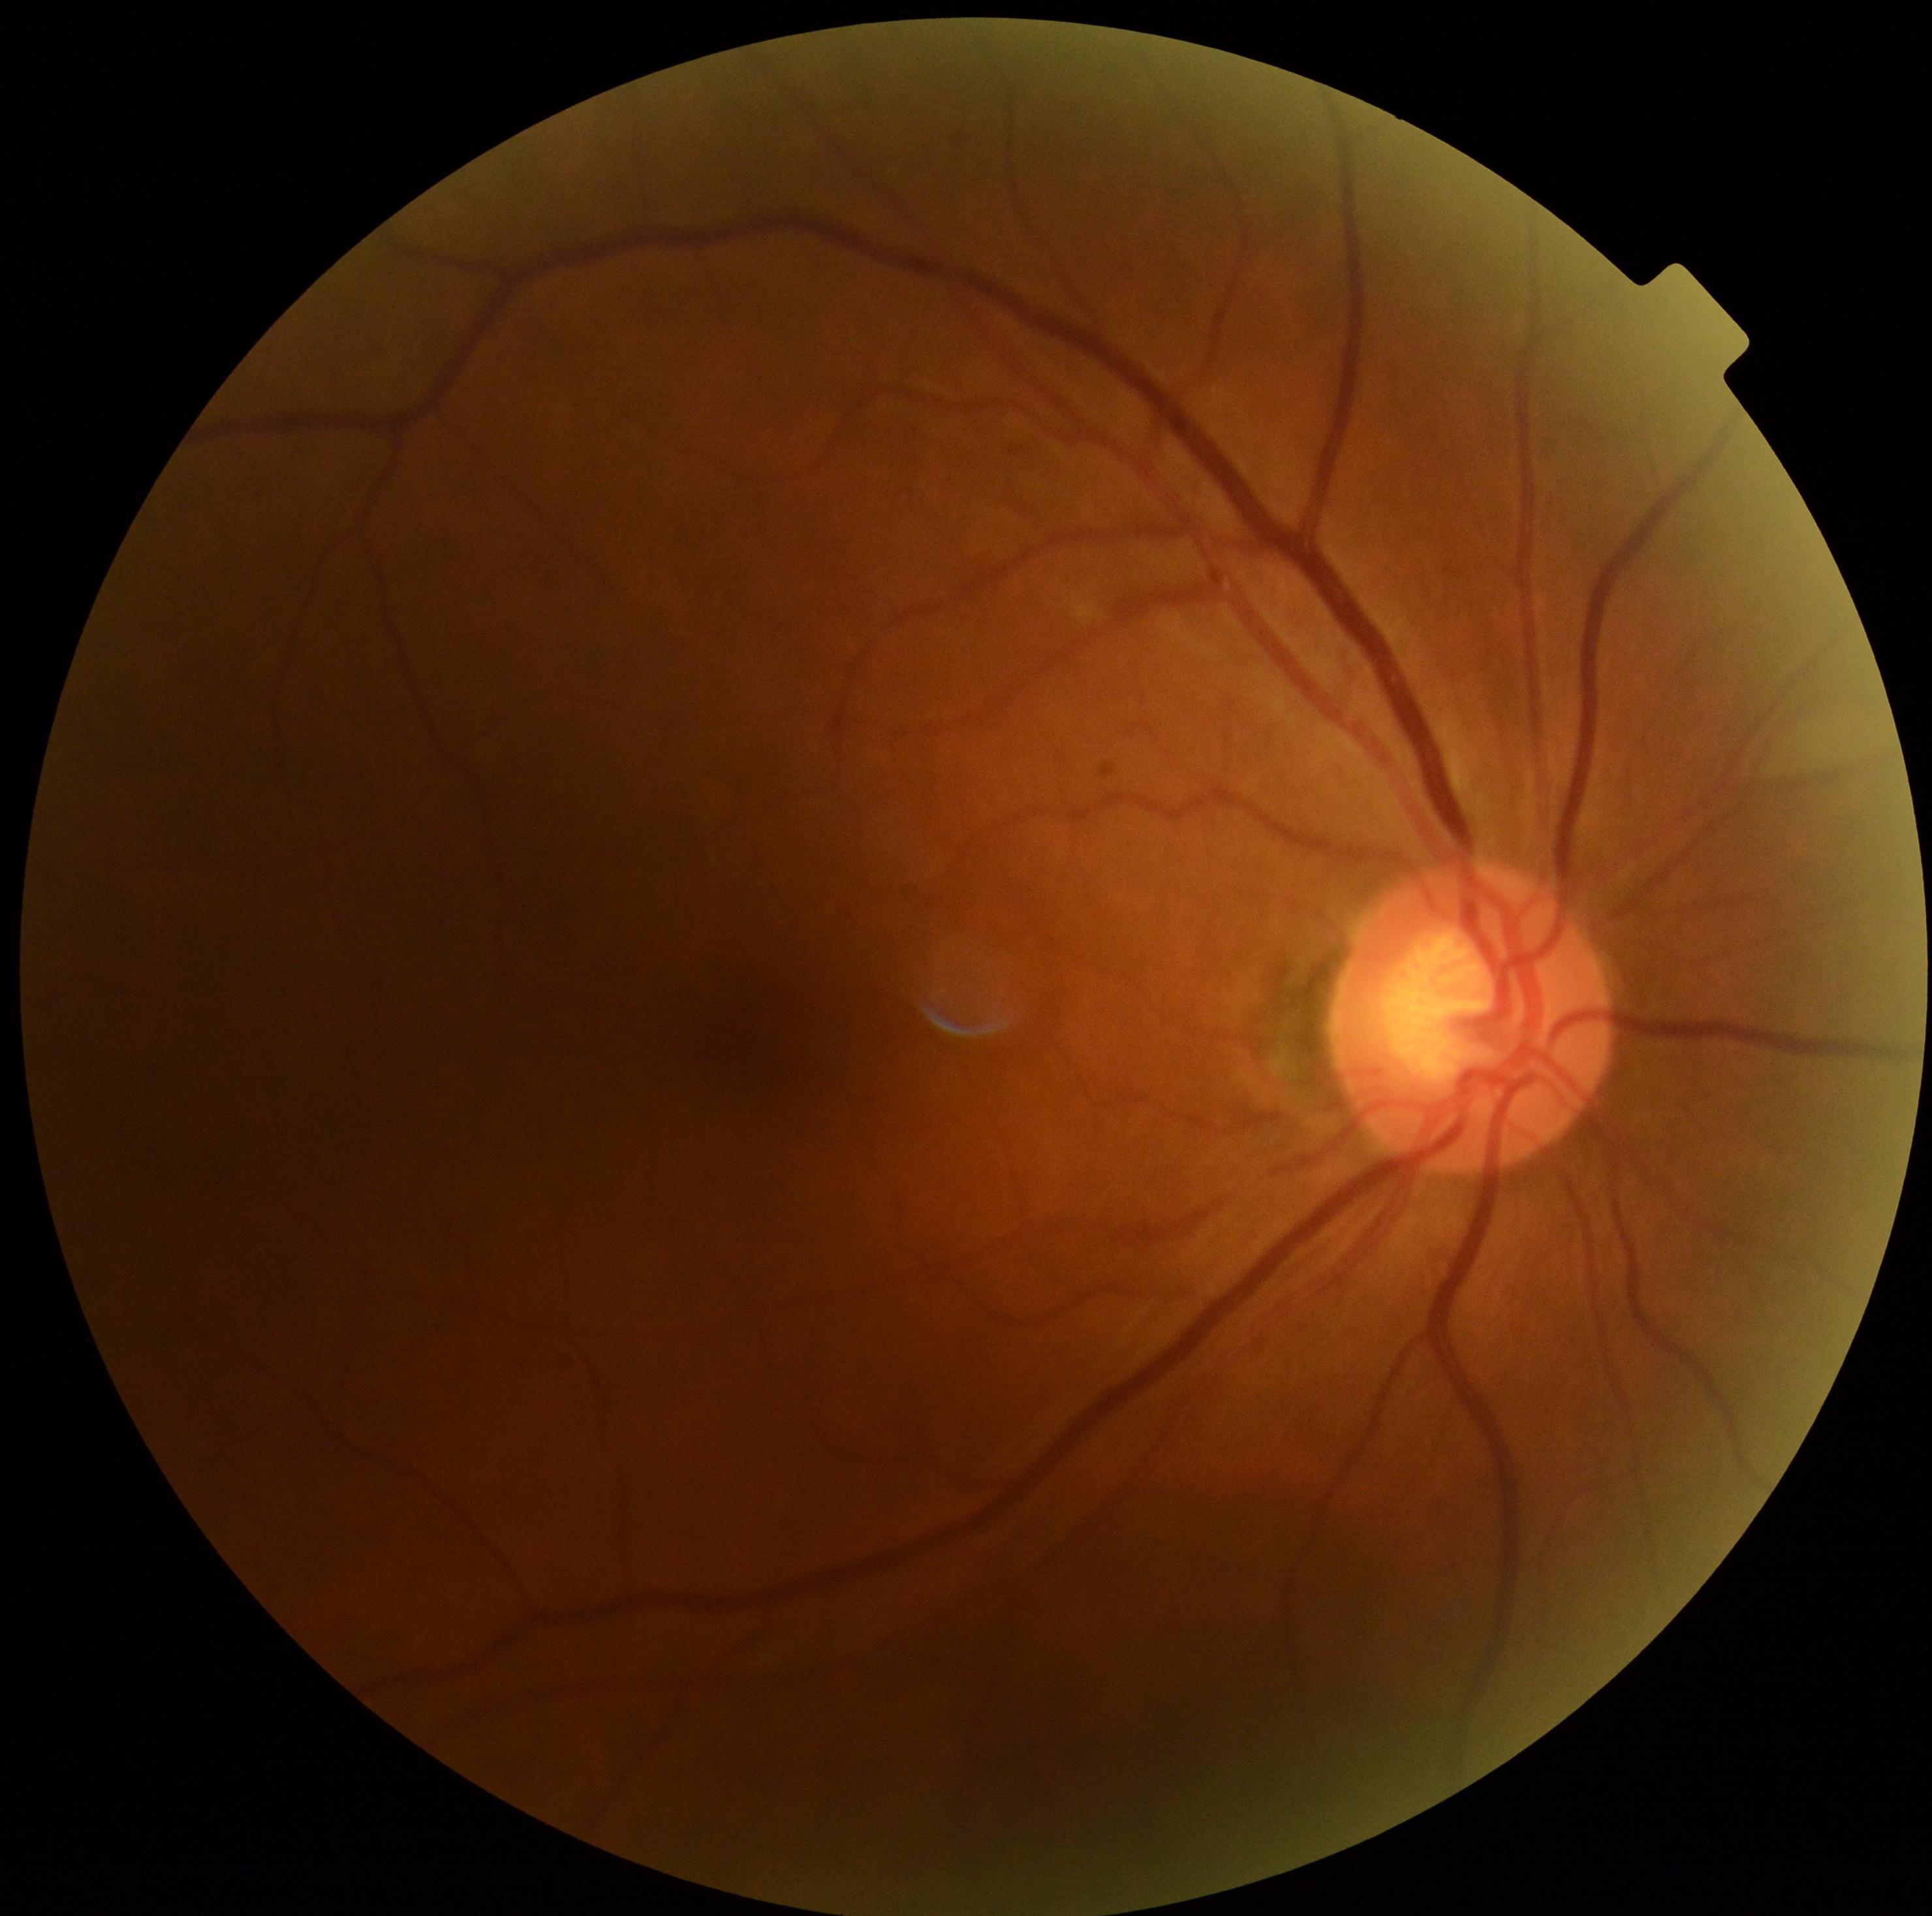 retinopathy grade: 0, DR impression: no apparent DR.